2048 x 1536 pixels
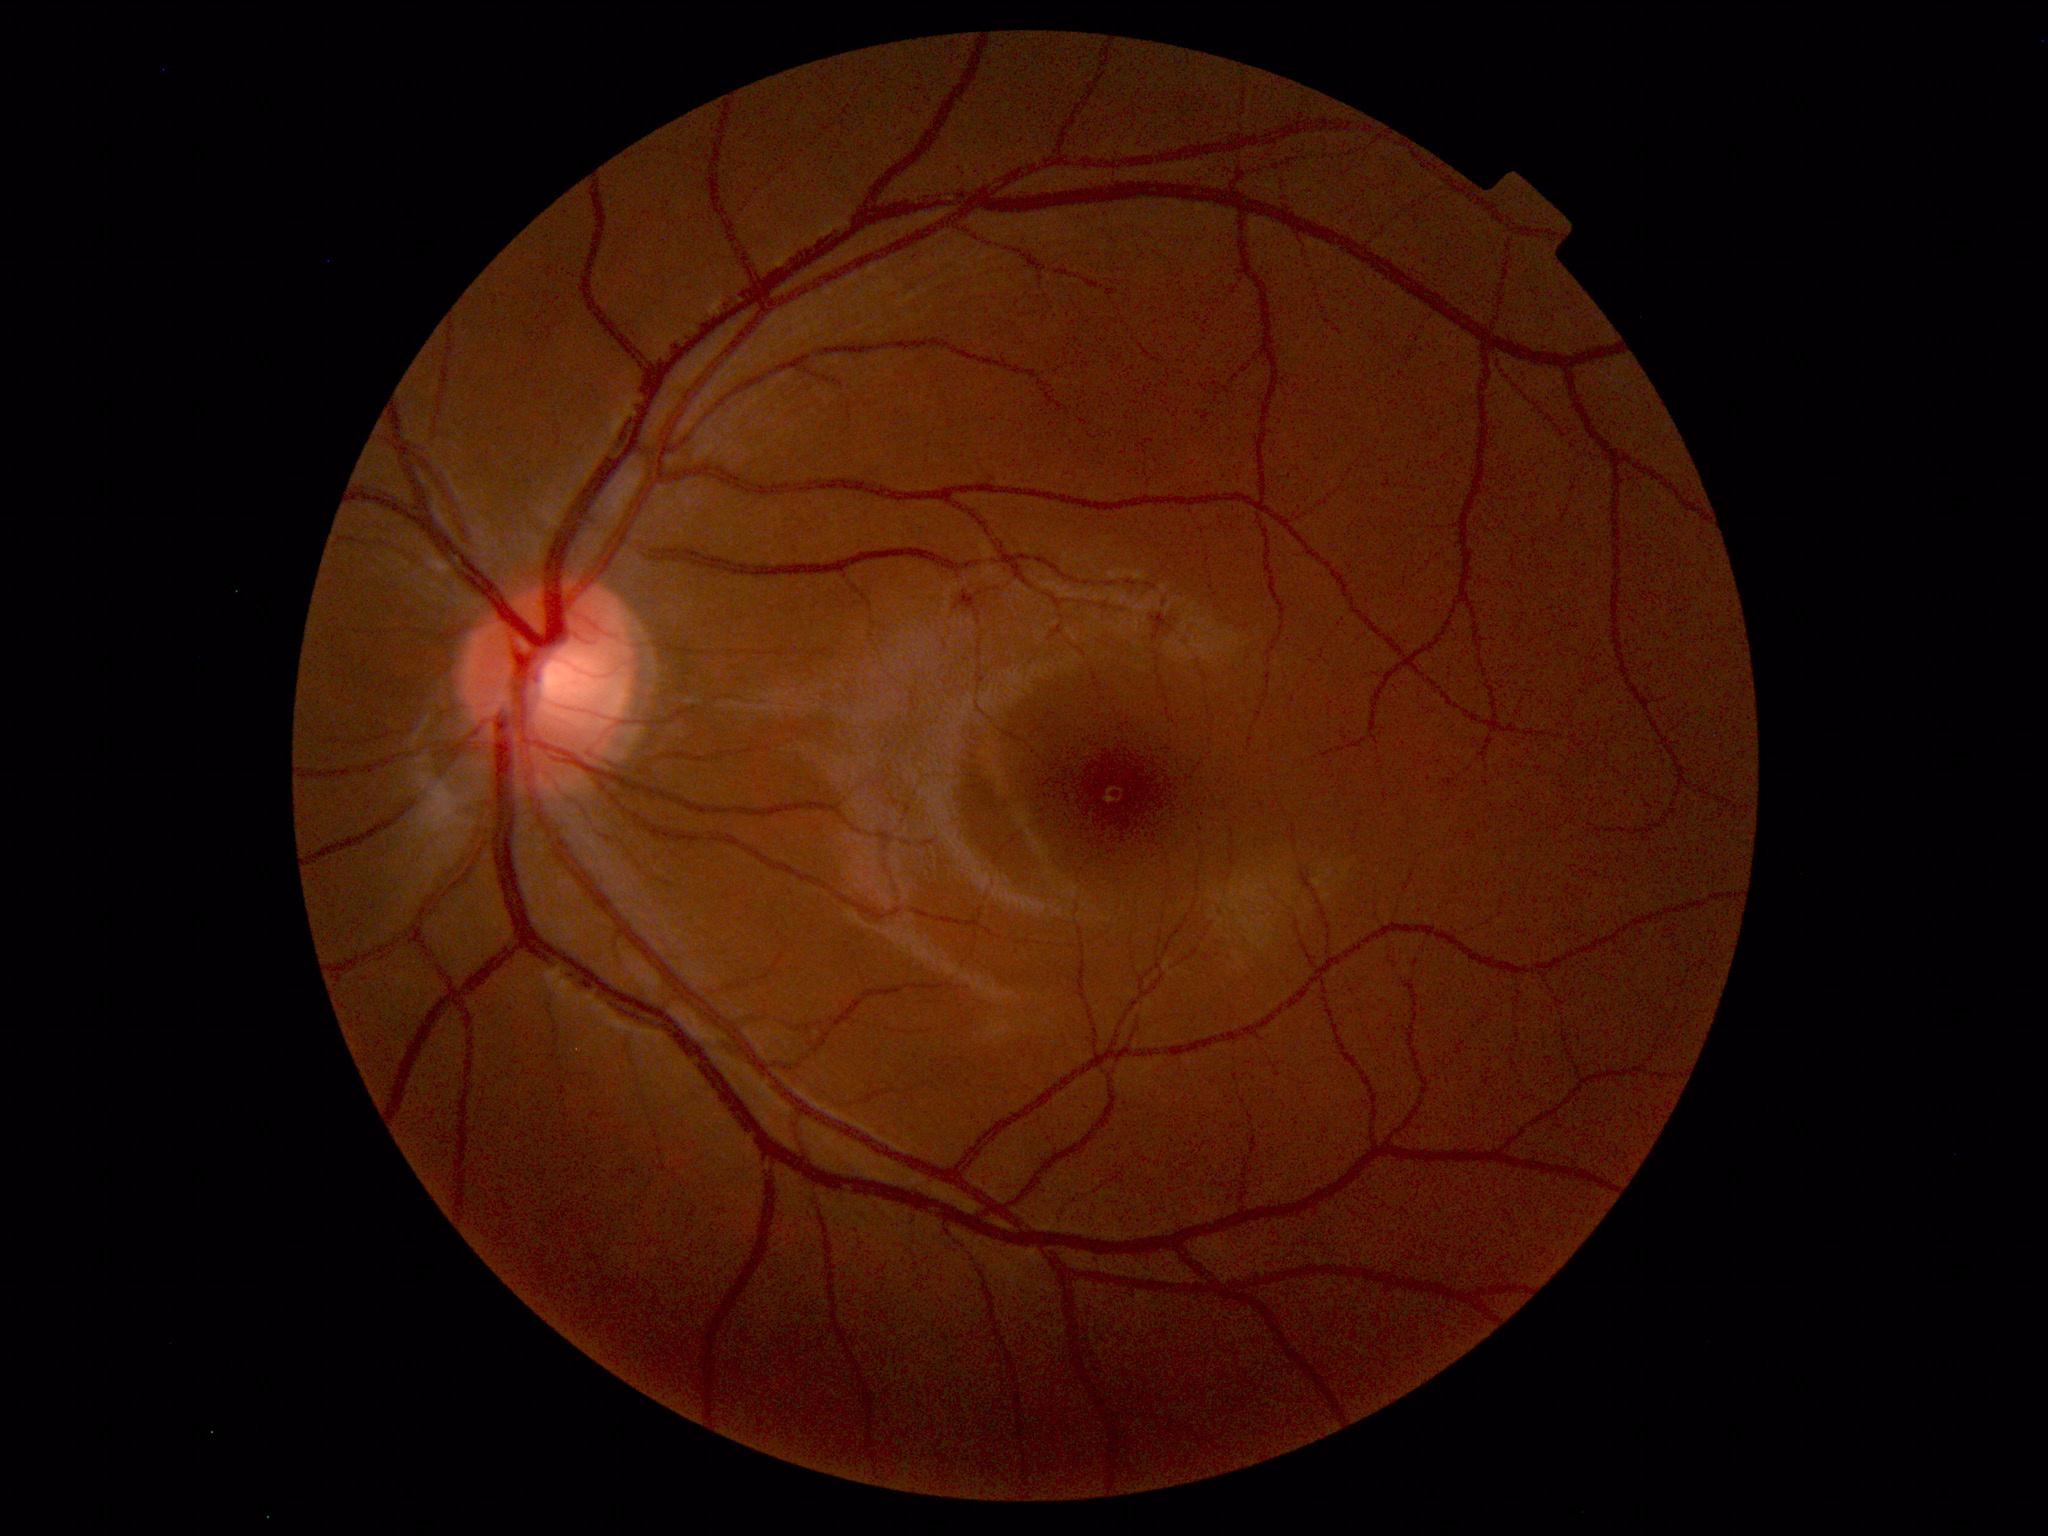
Unremarkable color fundus photograph.